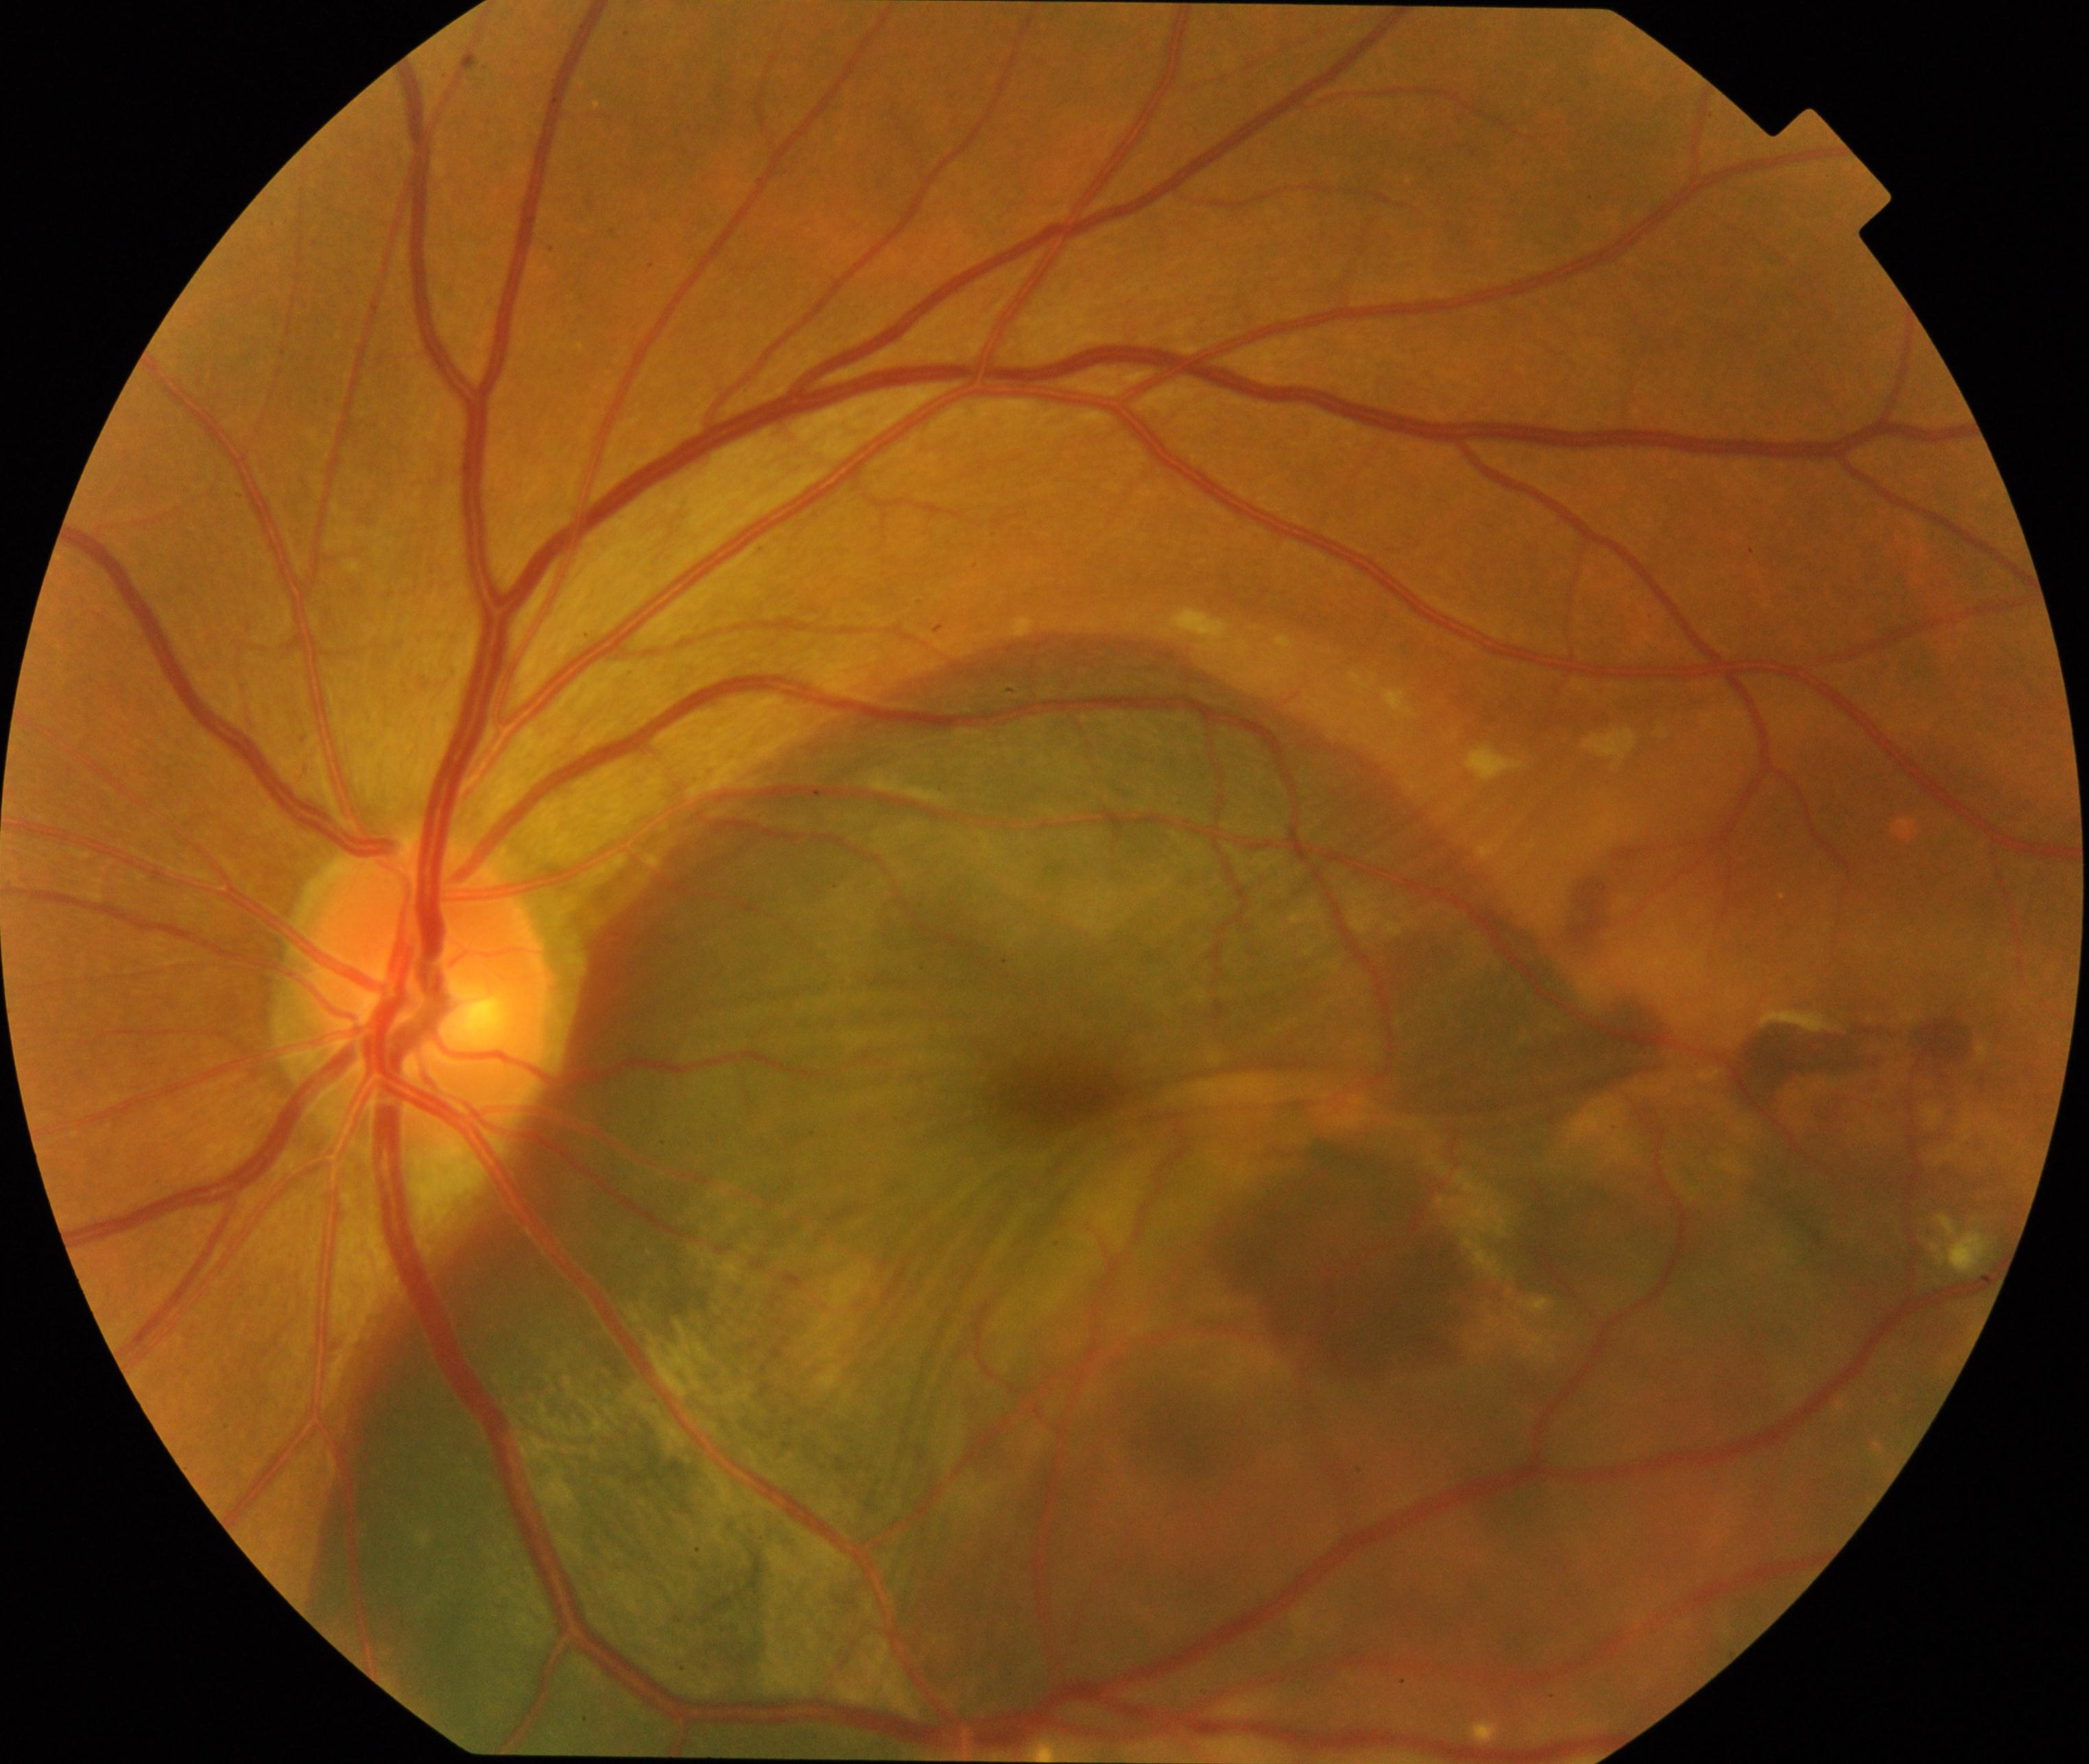
Consistent with maculopathy.